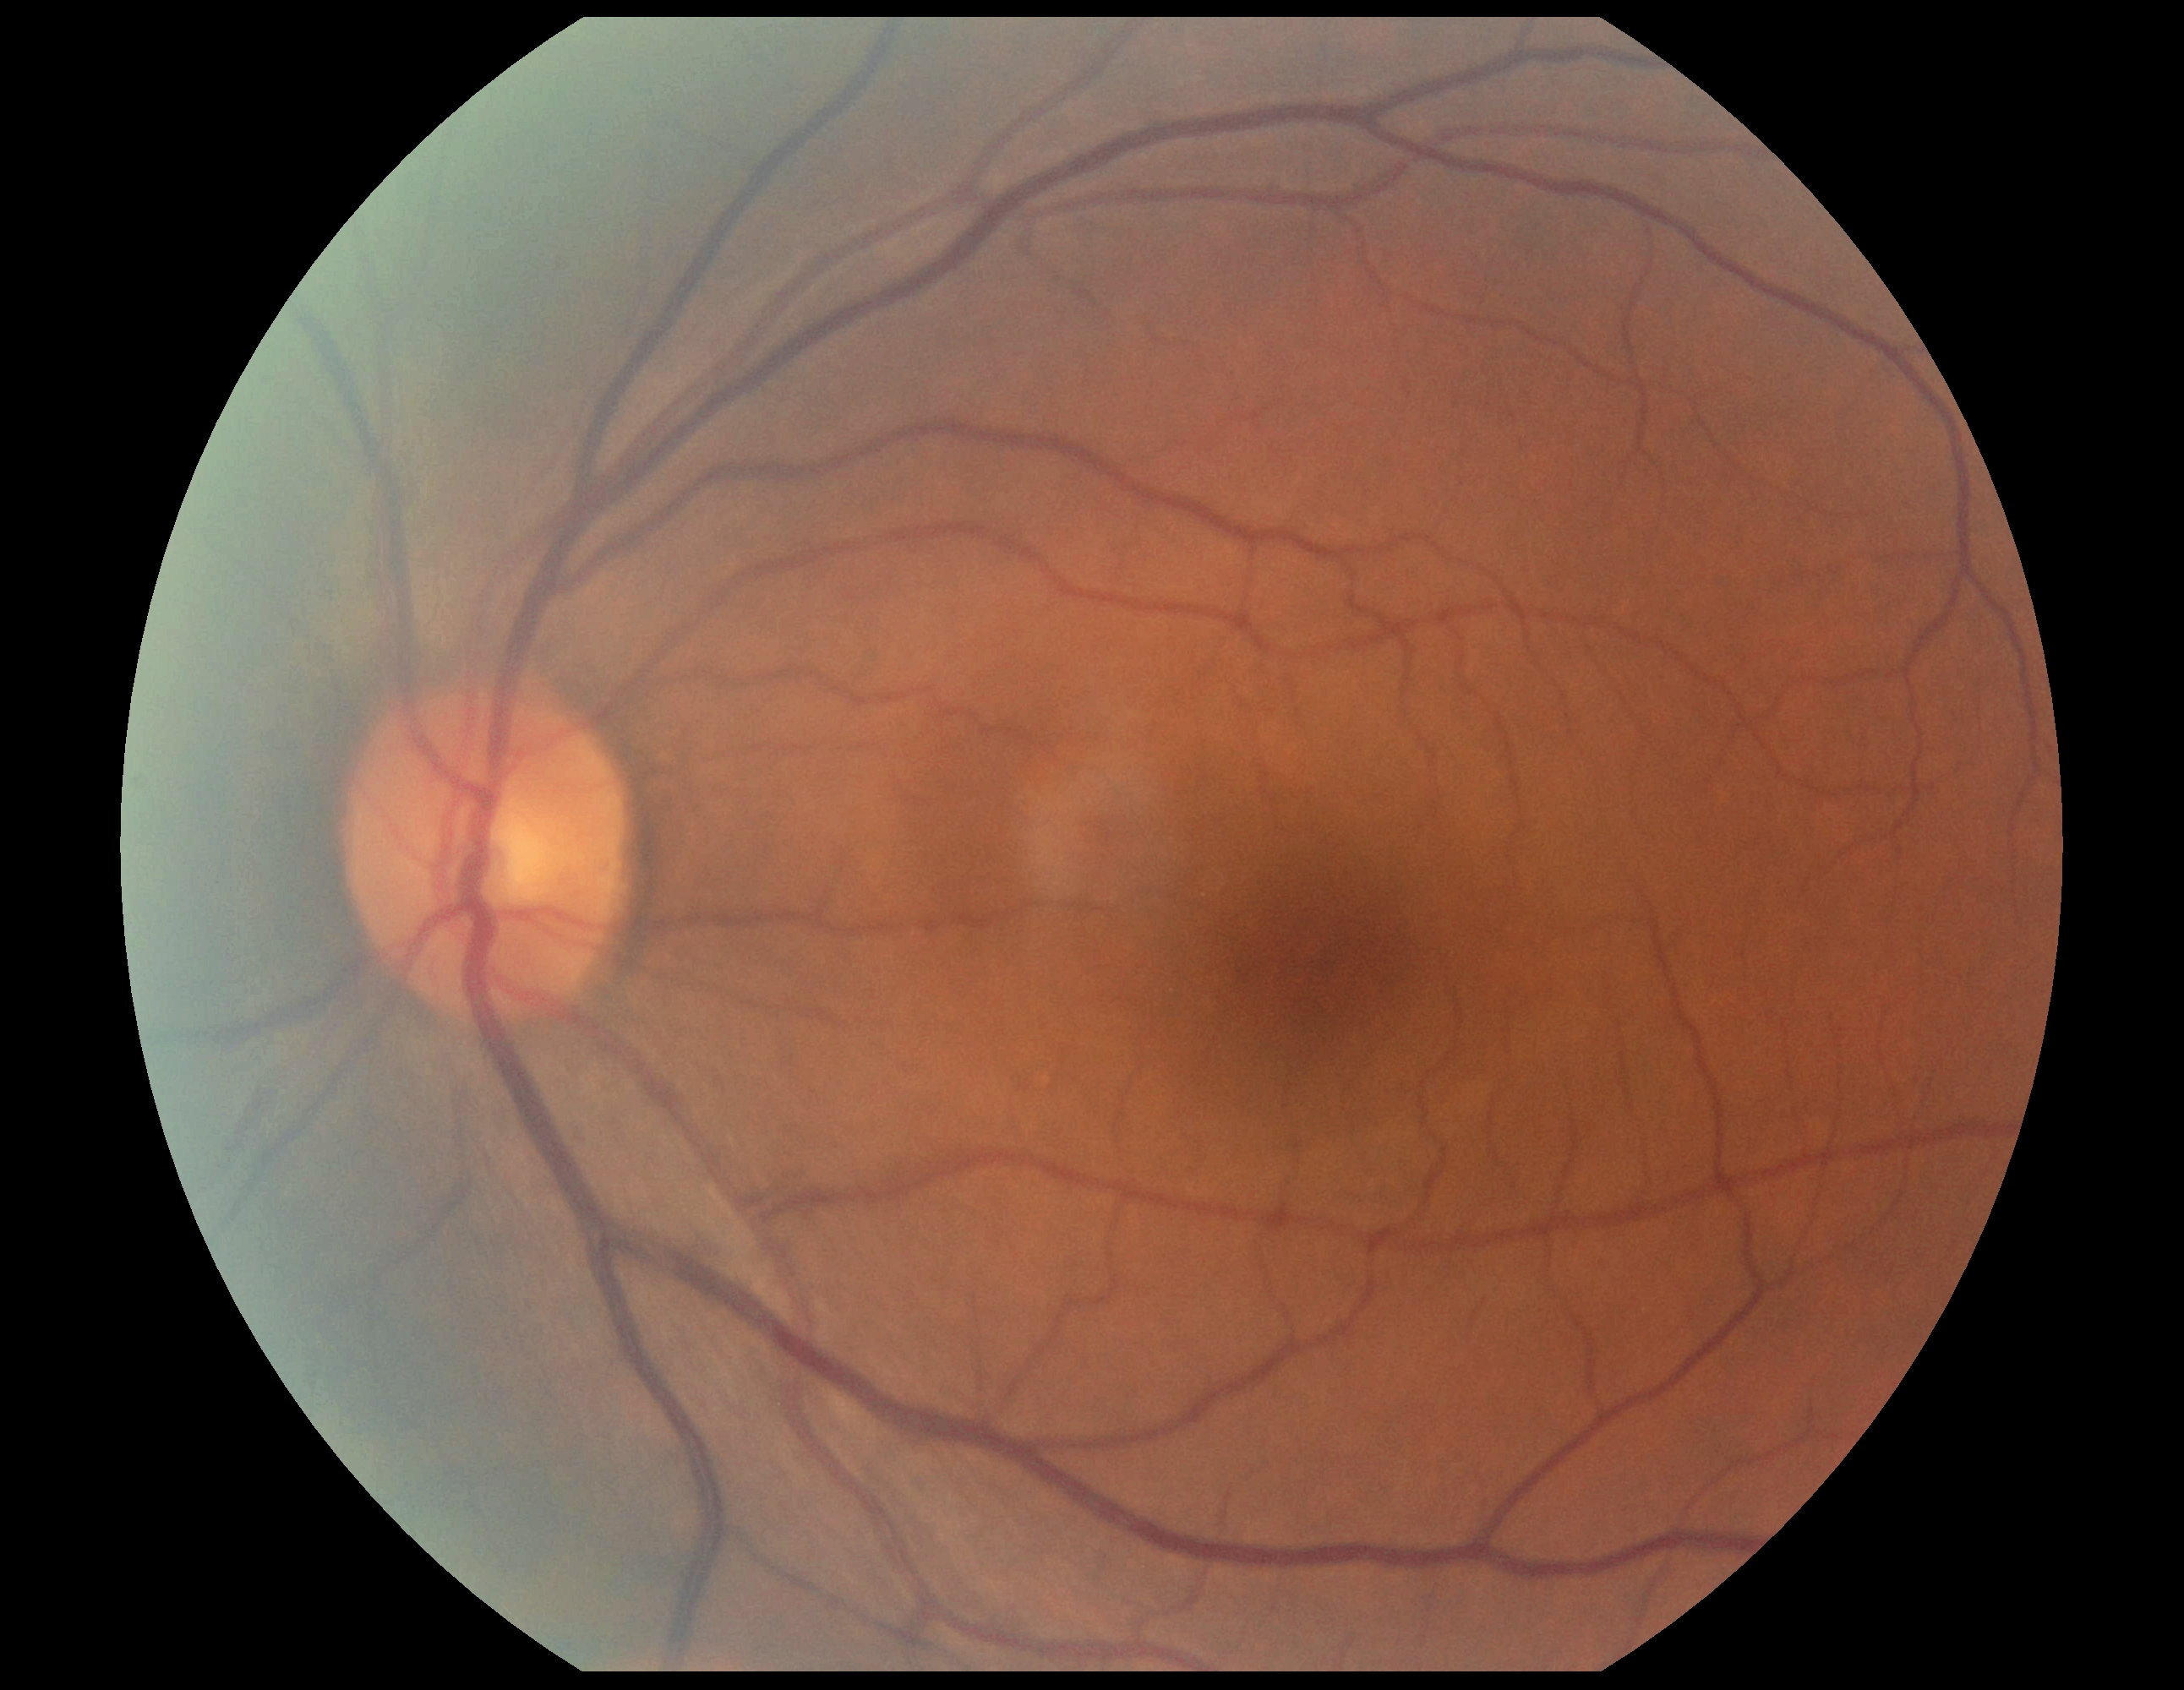 diabetic retinopathy severity = grade 0 (no apparent retinopathy)
DR impression = no DR findings